NIDEK AFC-230 fundus camera.
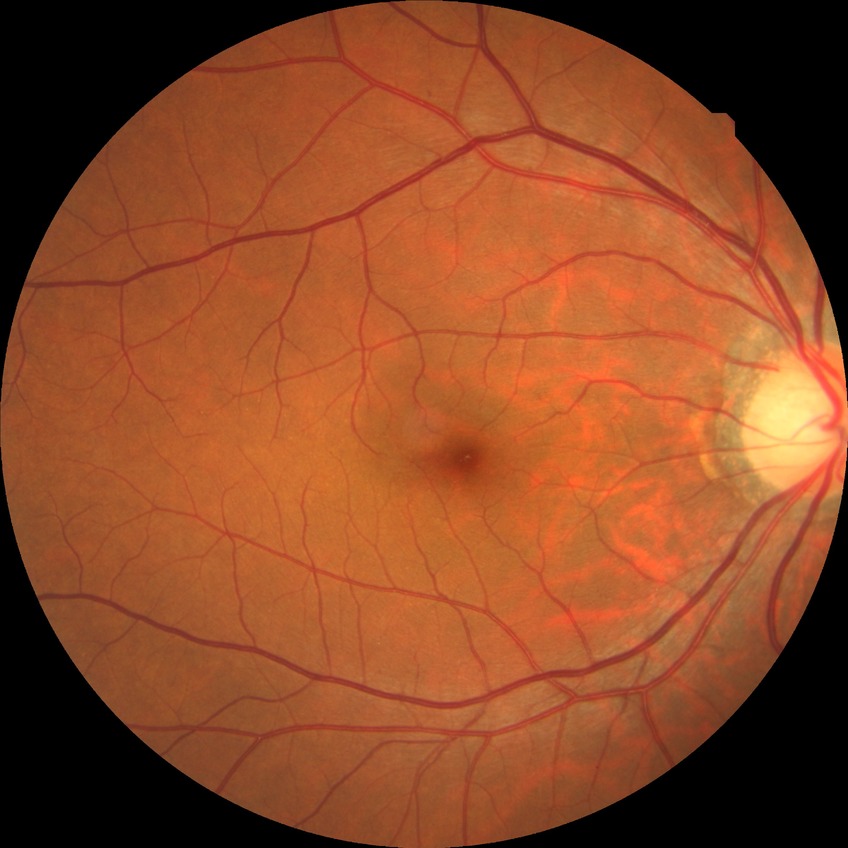

  davis_grade: no diabetic retinopathy